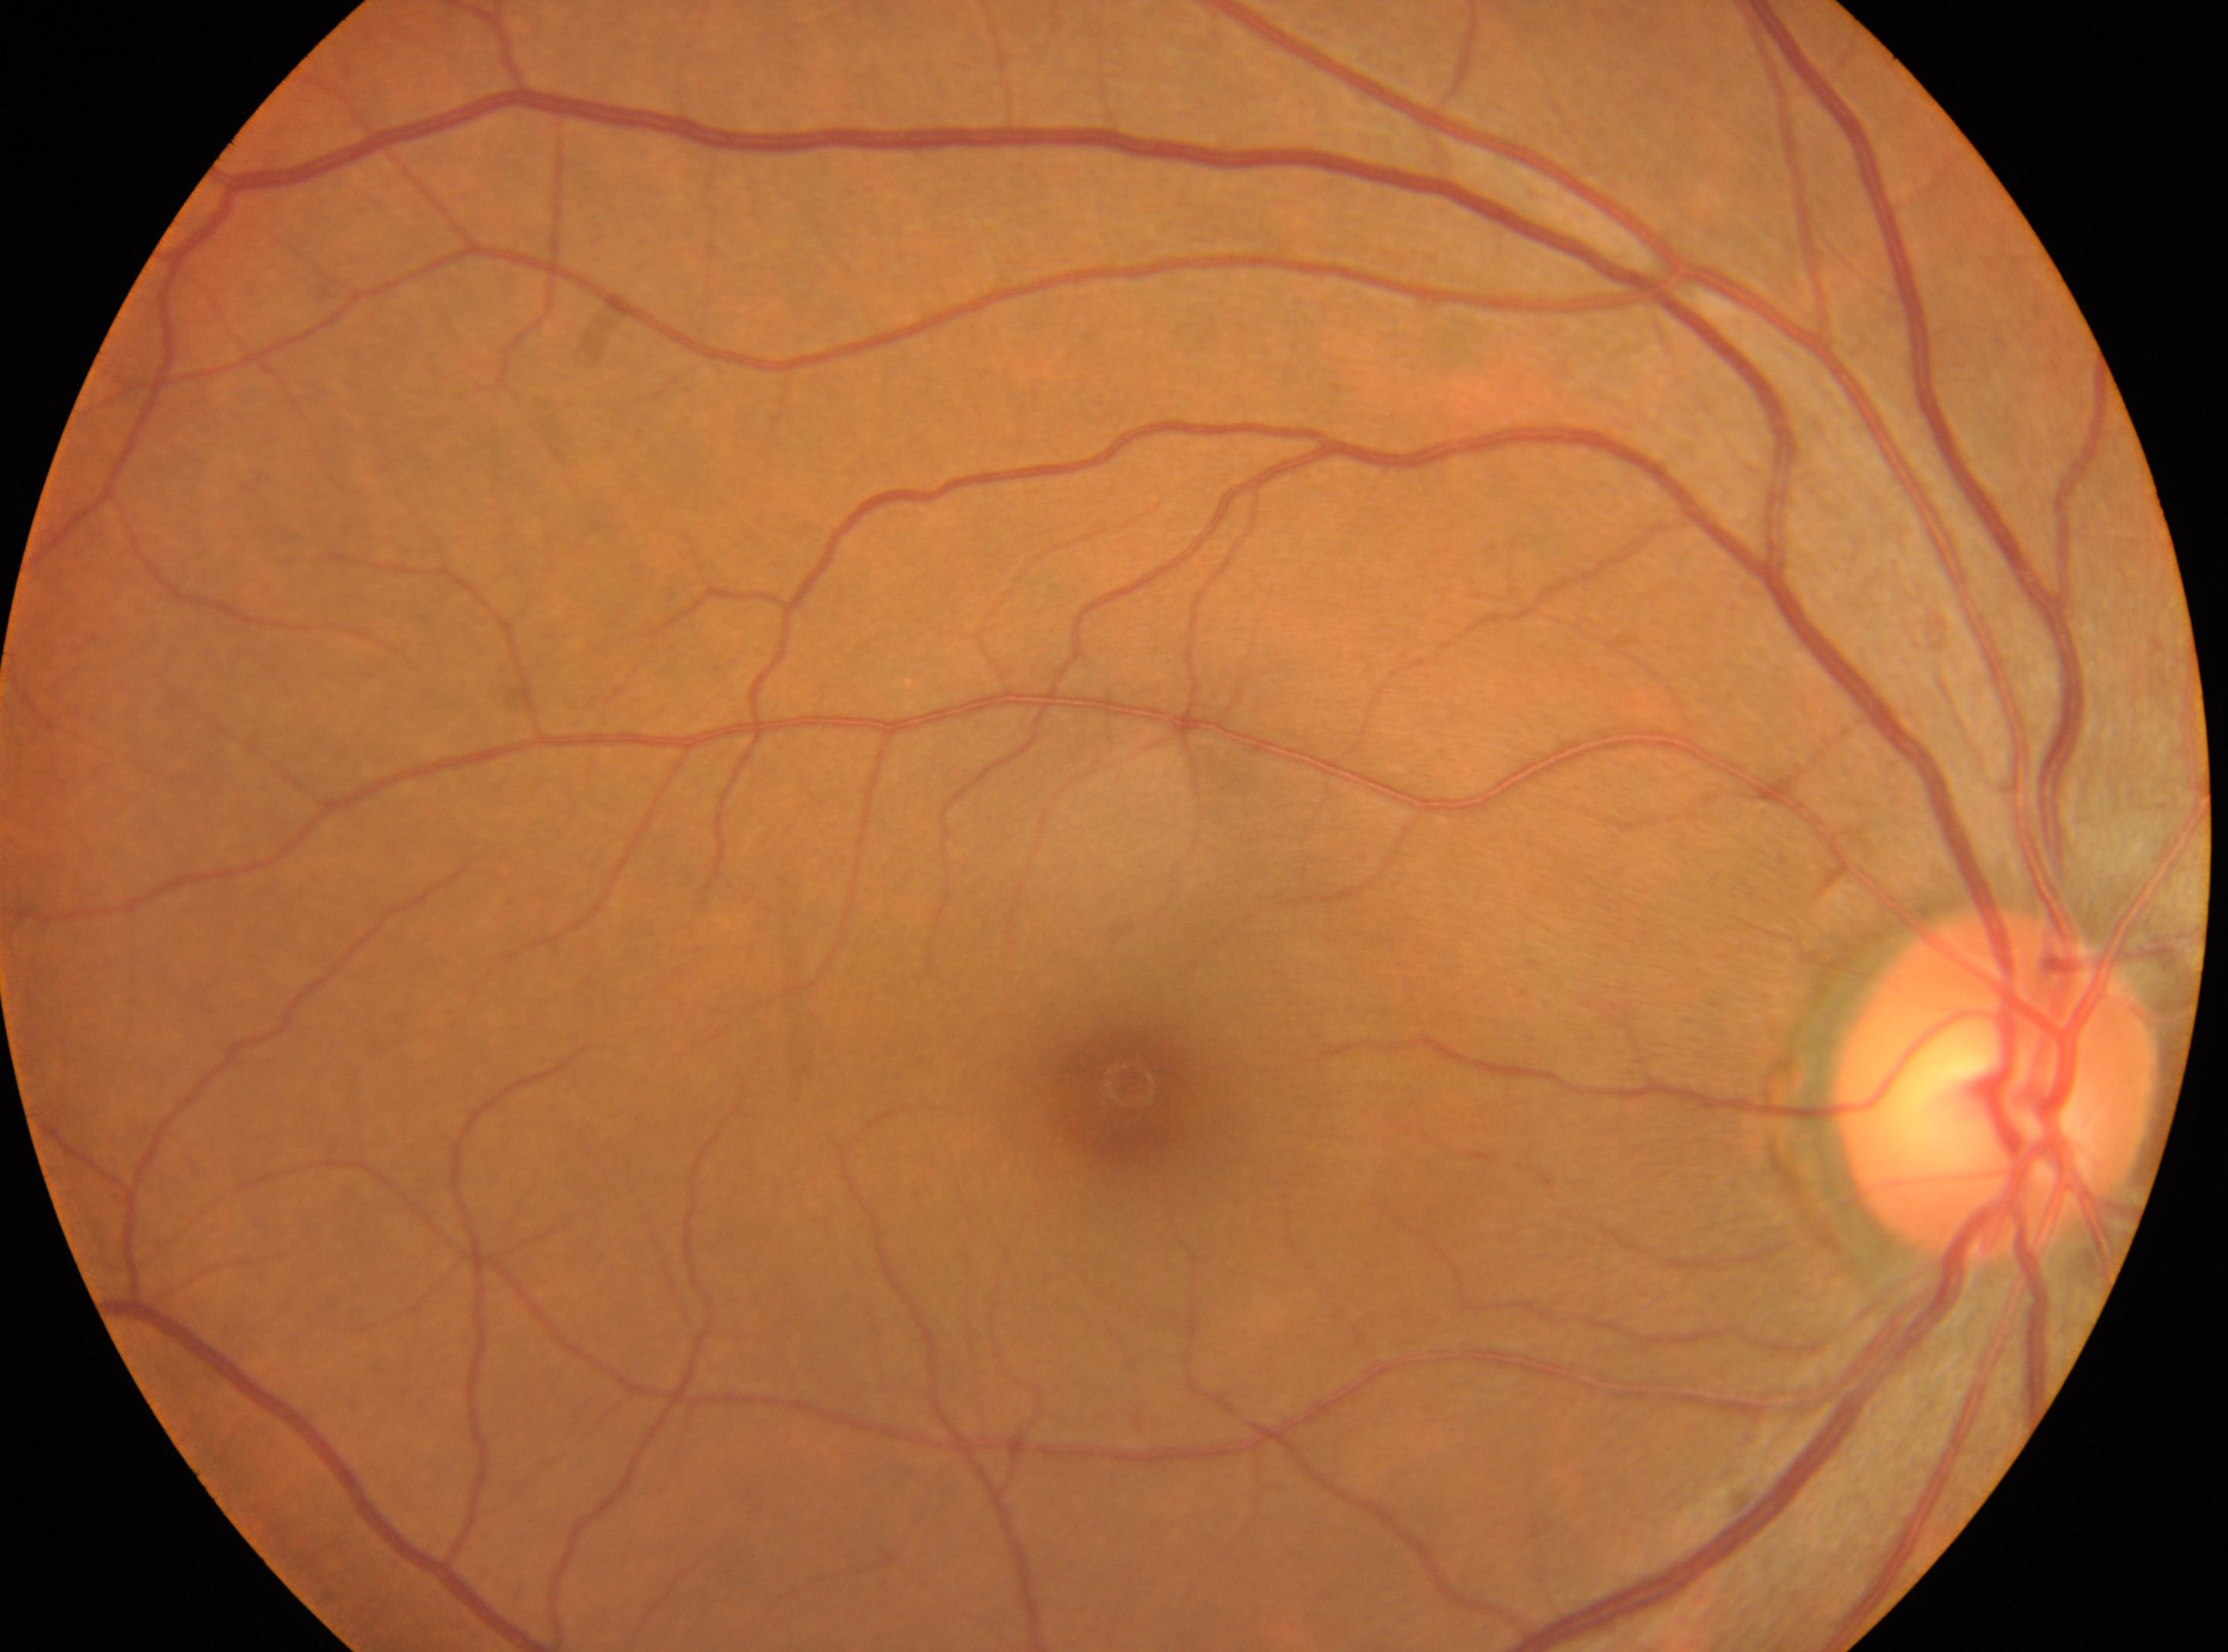 {"eye": "OD", "optic_disc": "(x=1994, y=1084)", "fovea": "(x=1129, y=1083)", "dr_grade": "0"}